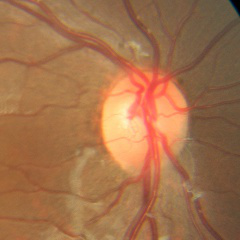

No glaucomatous findings.